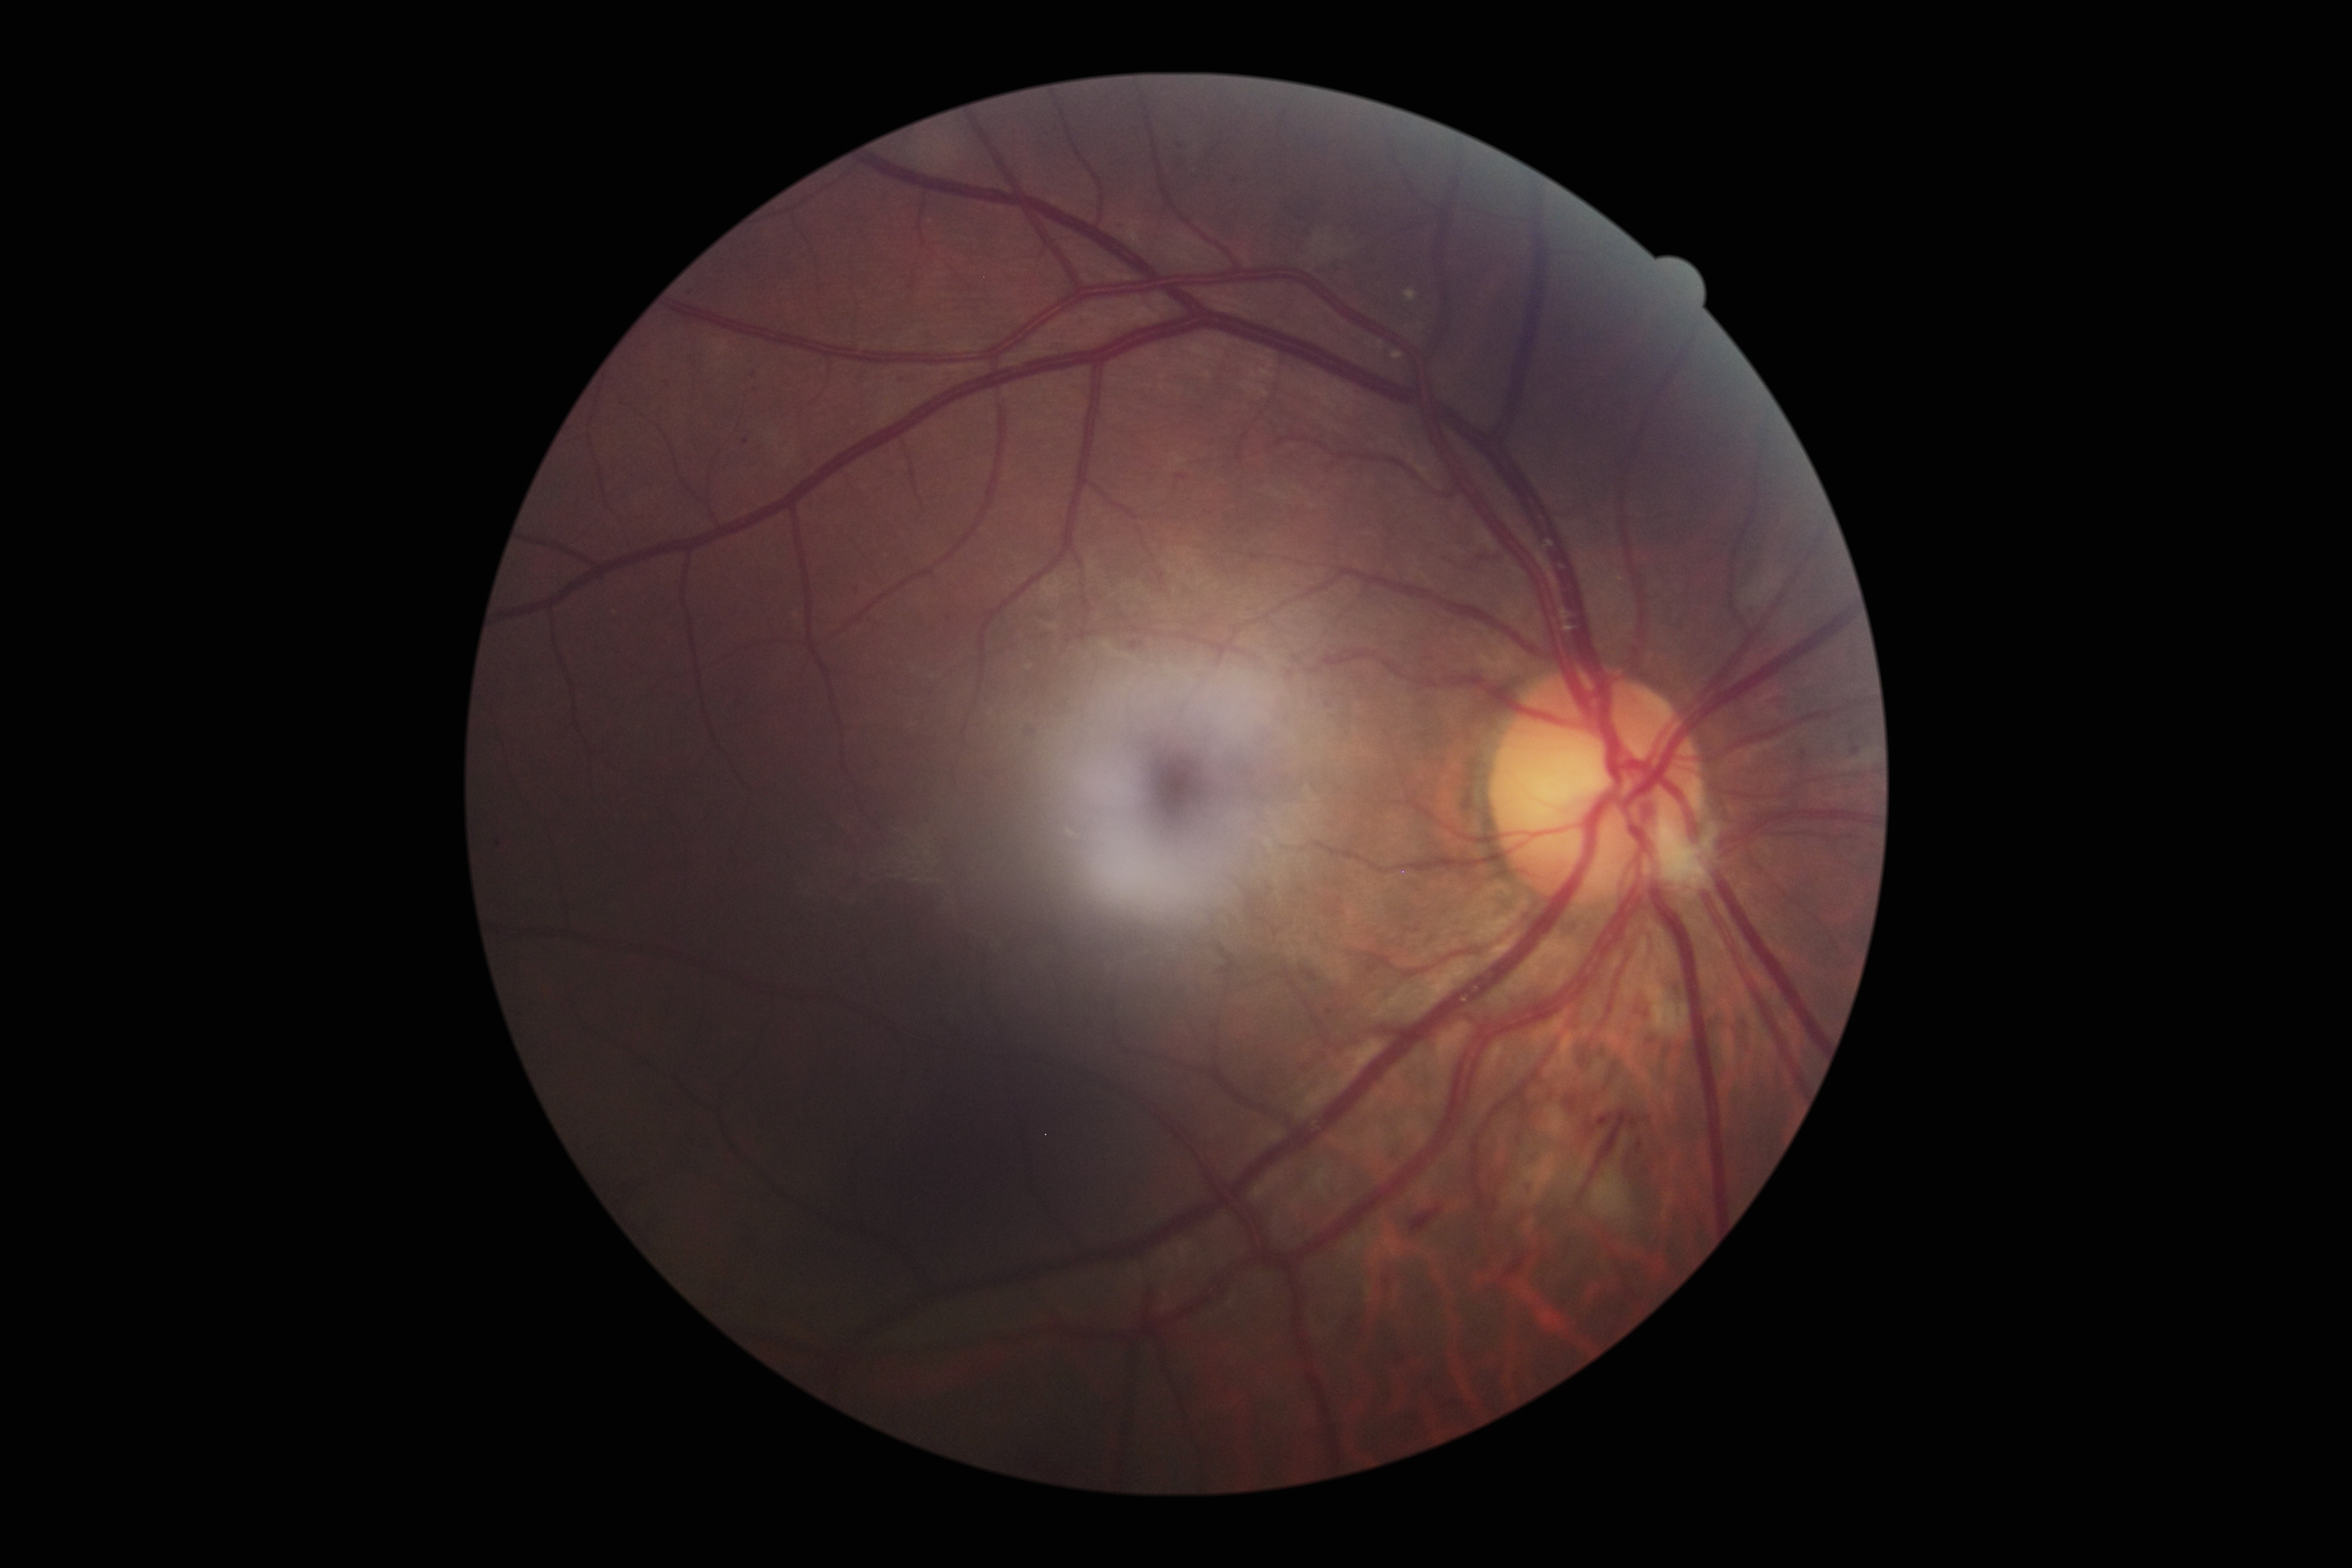 Diabetic retinopathy (DR) is moderate non-proliferative diabetic retinopathy (grade 2).